Fundus photo · 2184 x 1690 pixels · 45° FOV: 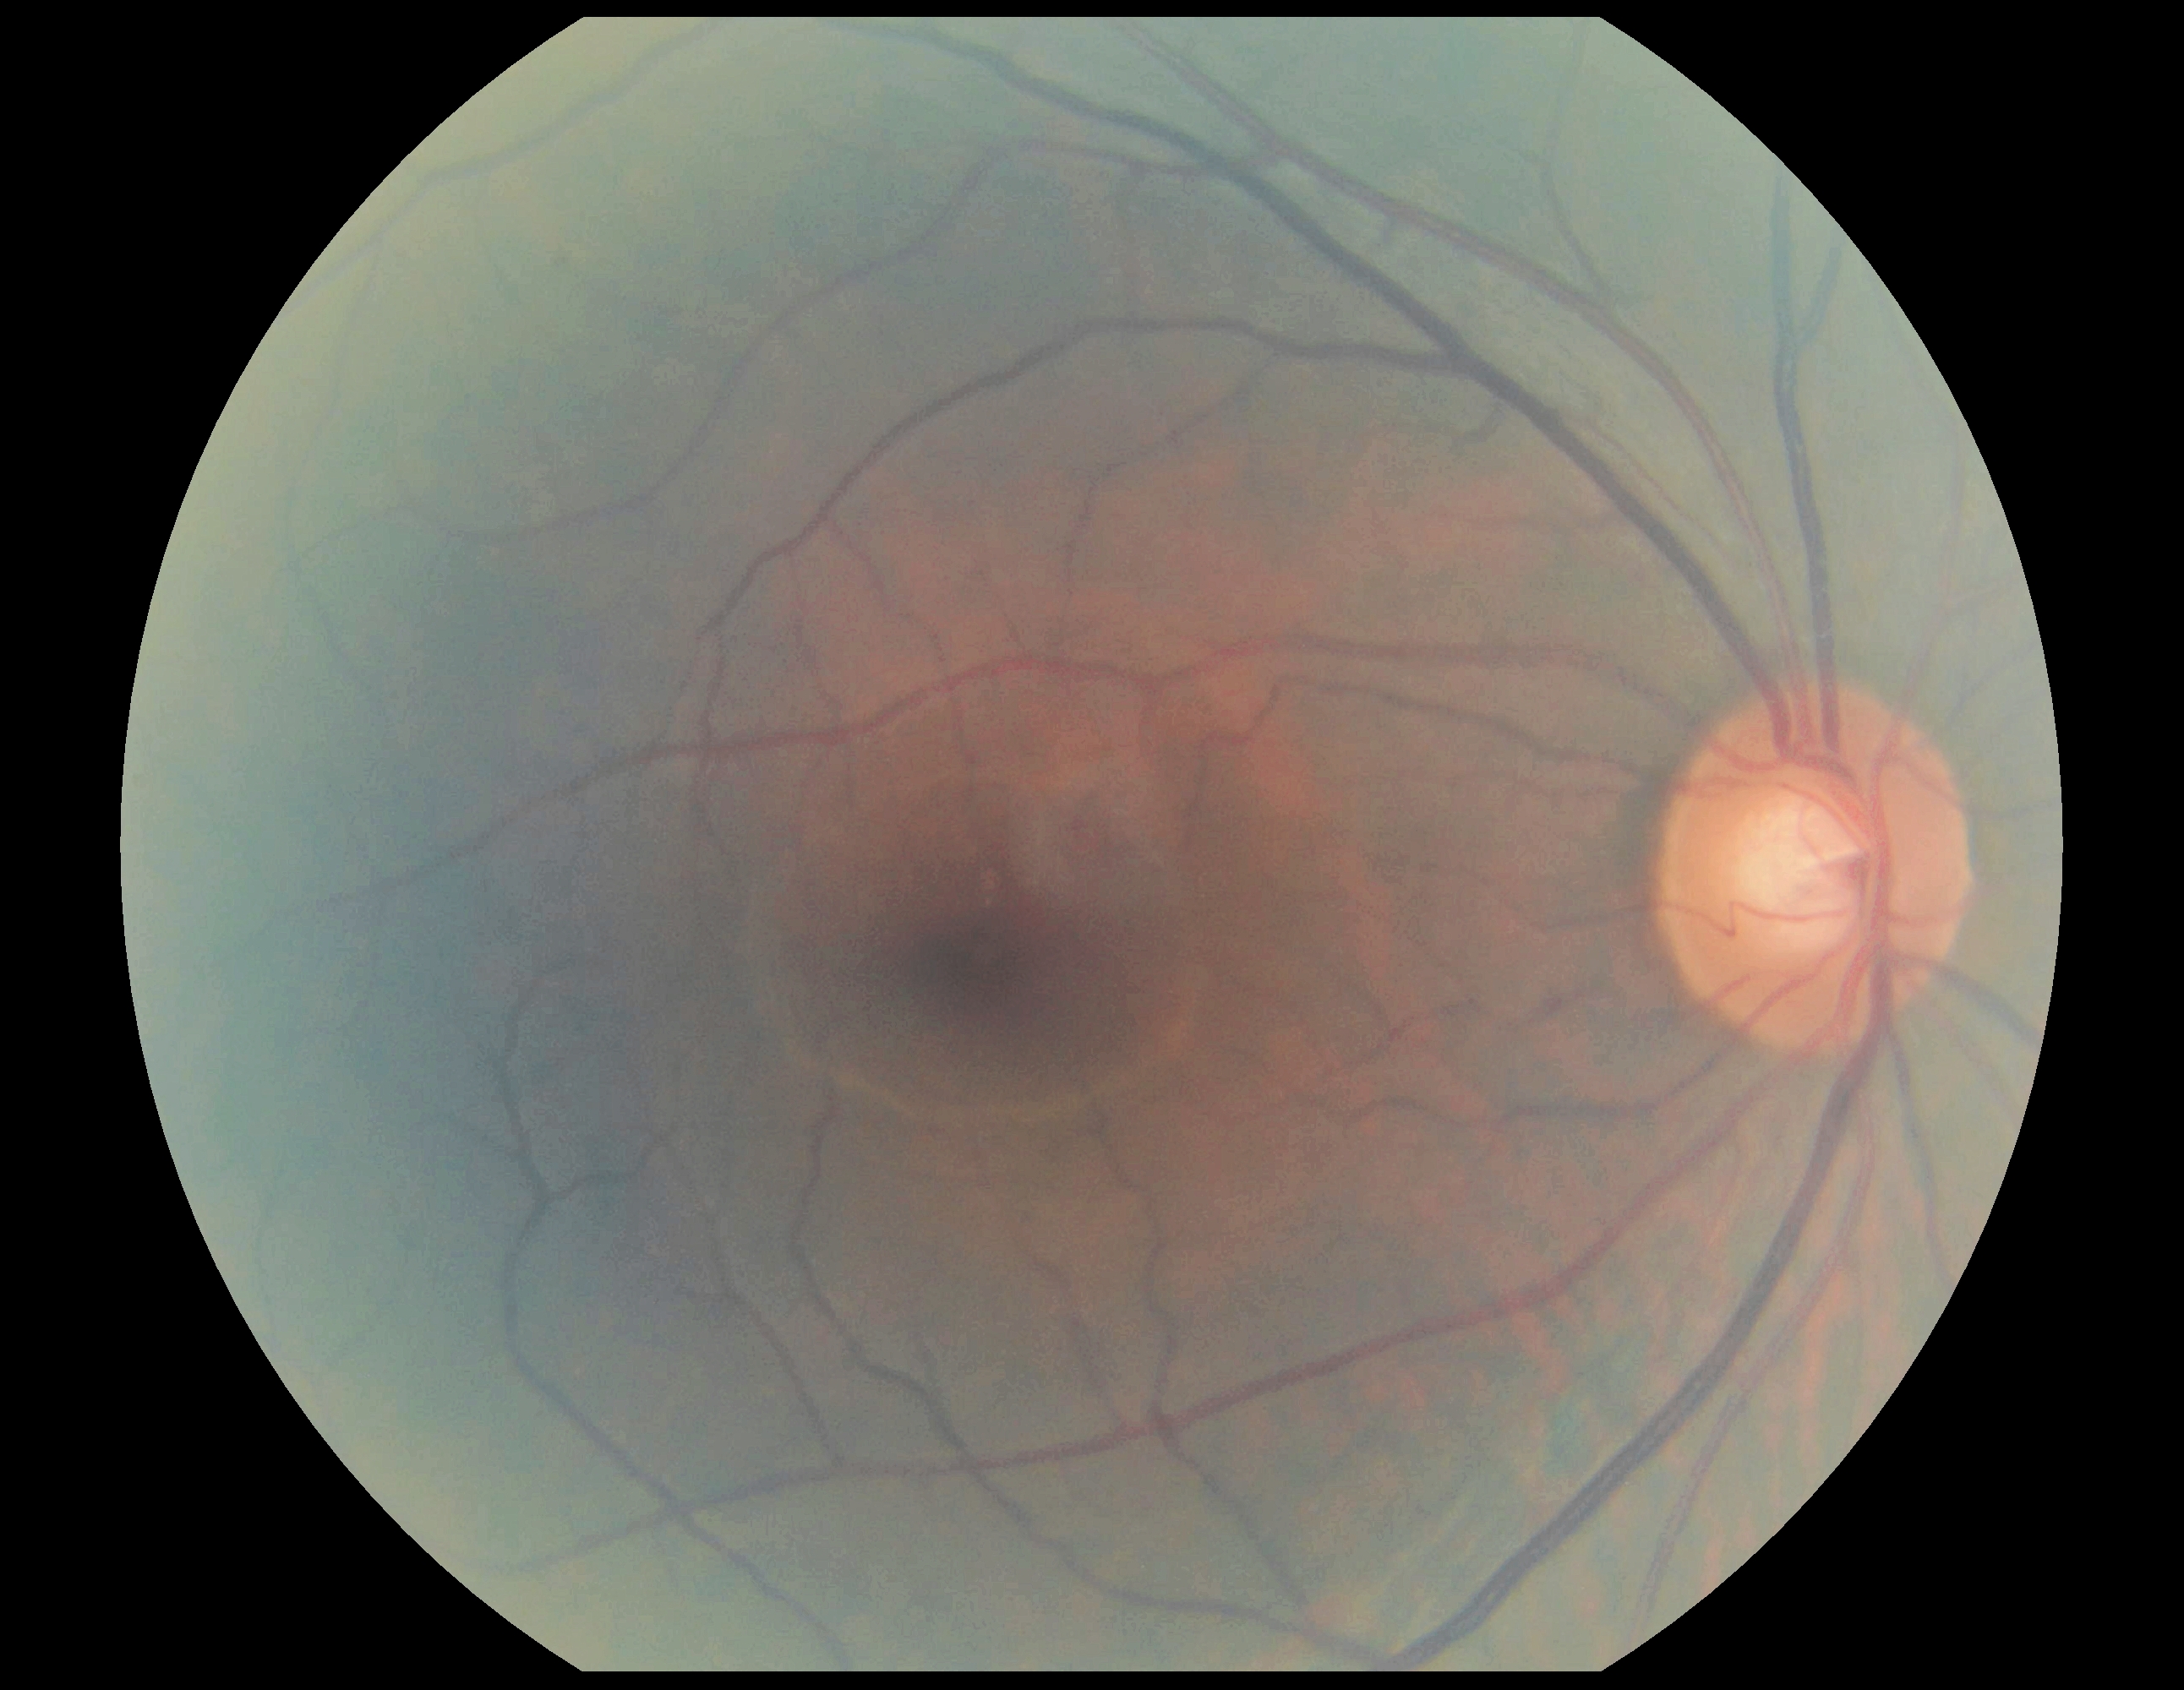
diabetic retinopathy severity: grade 0 (no apparent retinopathy)
DR impression: no signs of DR